Retinal fundus photograph: 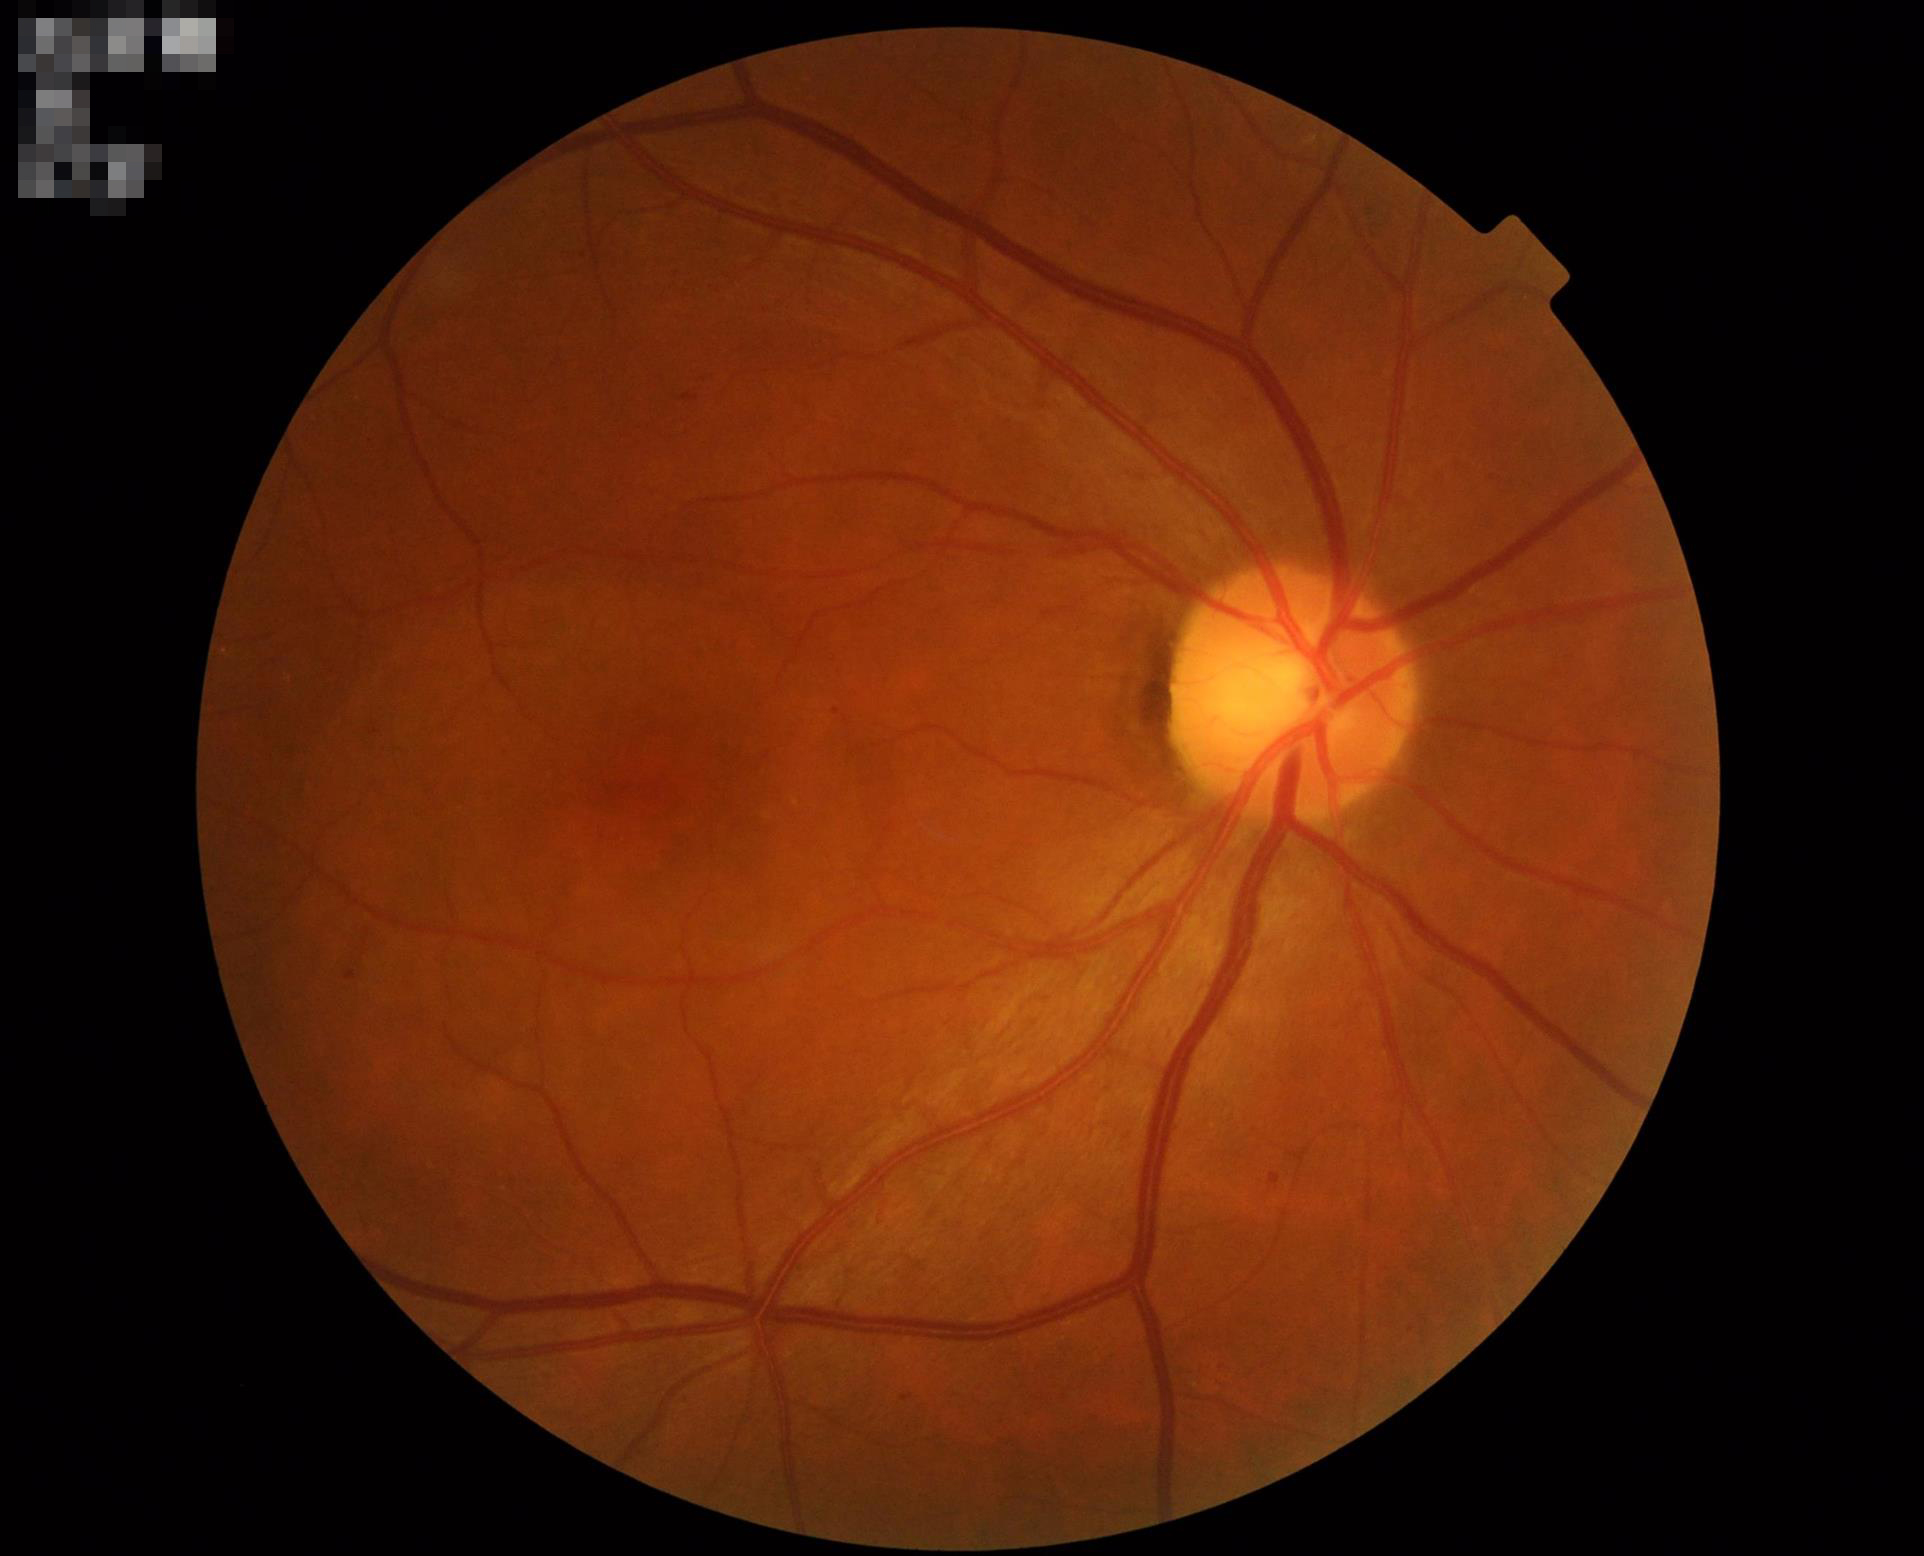

Clarity = sharp
Overall quality = good
Contrast = adequate